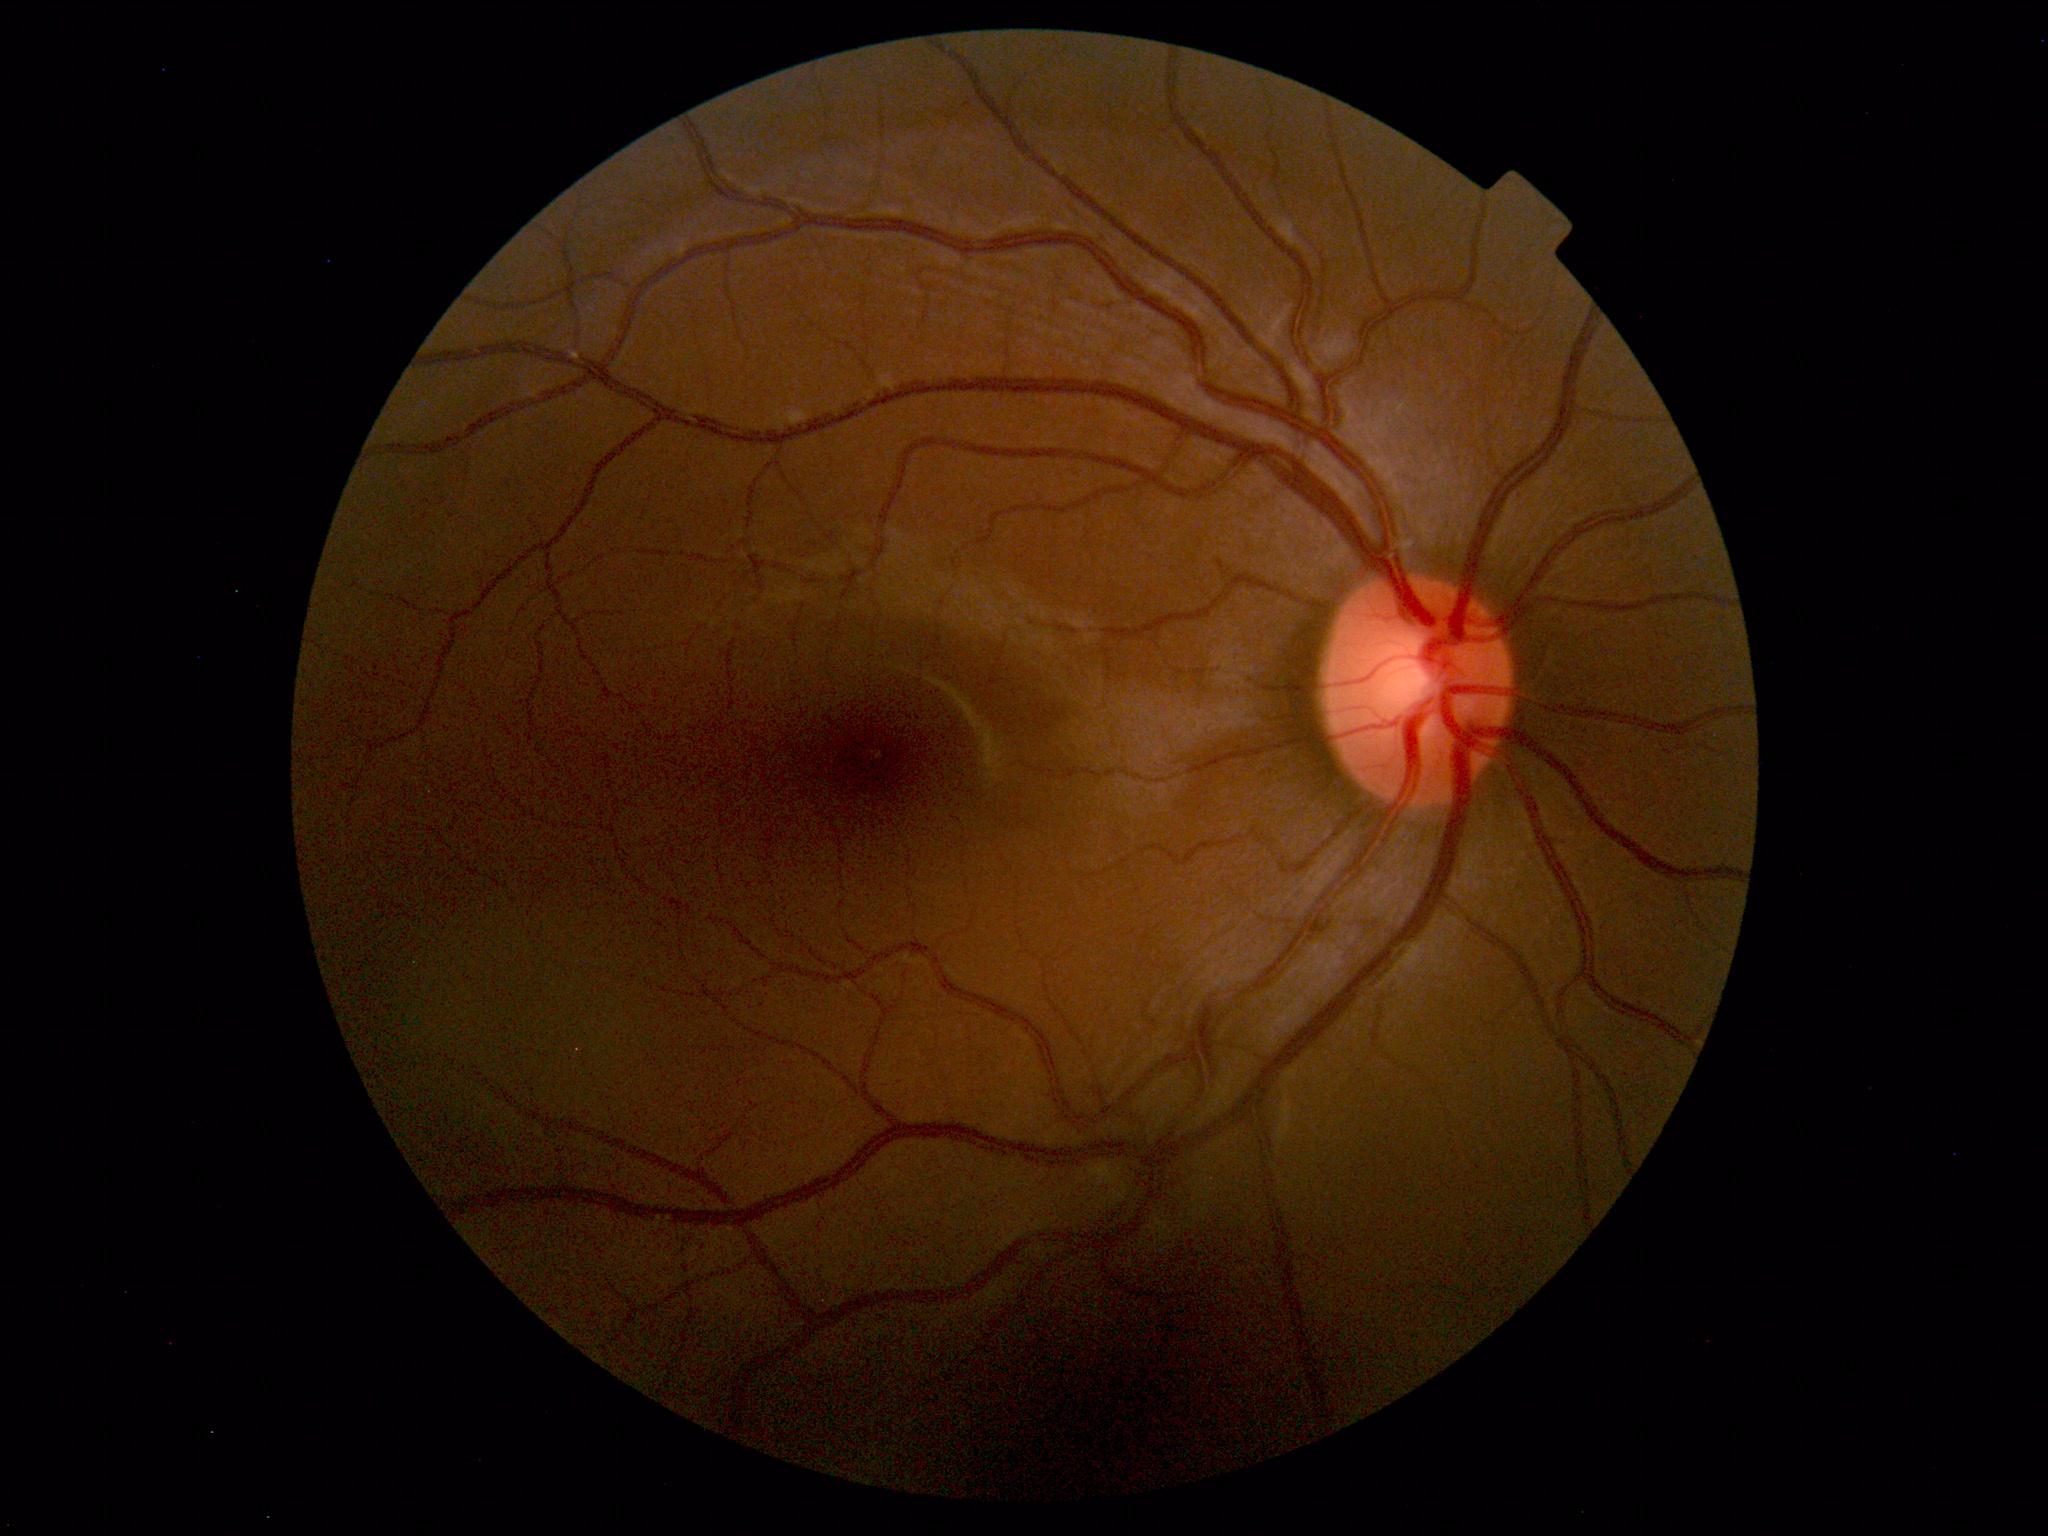
Within normal limits. No abnormalities identified.